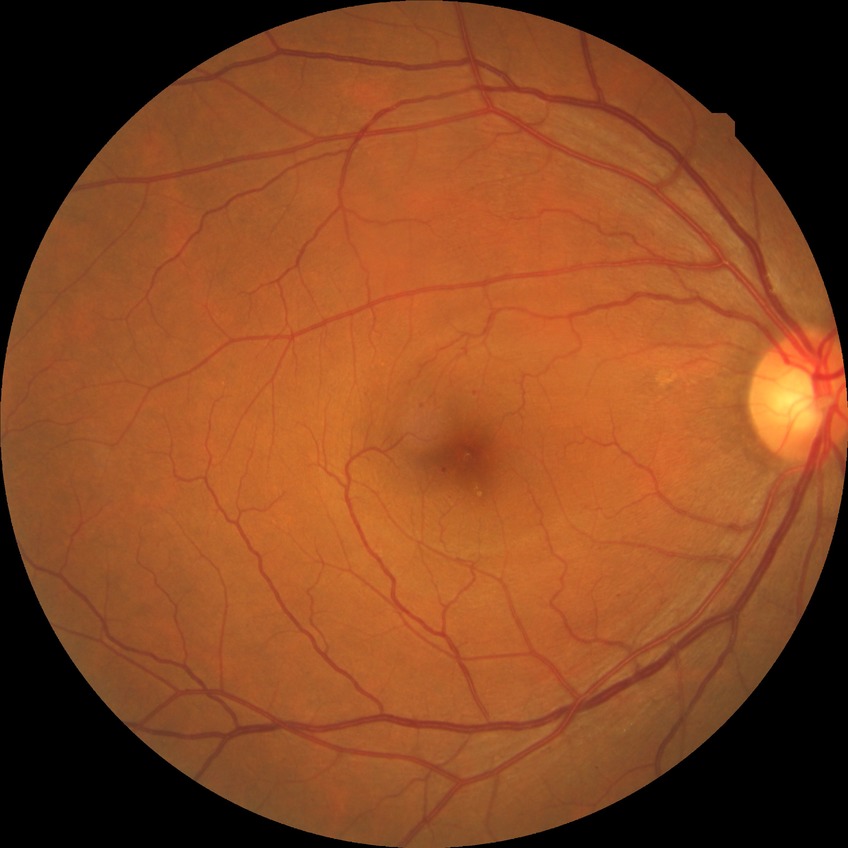

Davis DR grade=SDR.